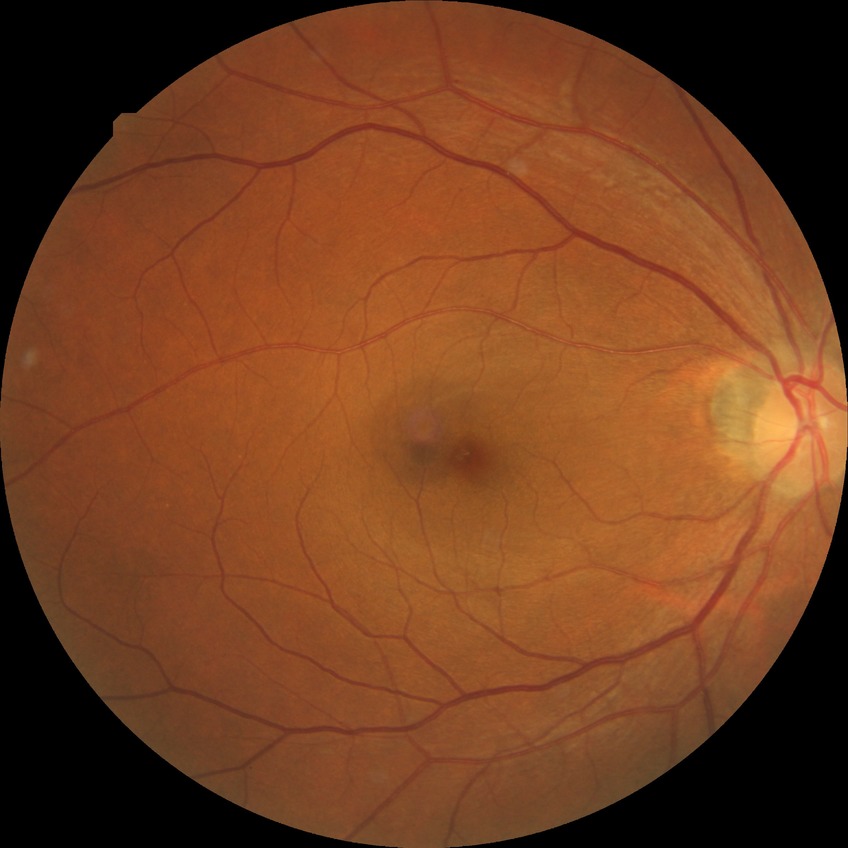 Davis DR grade is SDR.